Nonmydriatic · 45 degree fundus photograph · NIDEK AFC-230 — 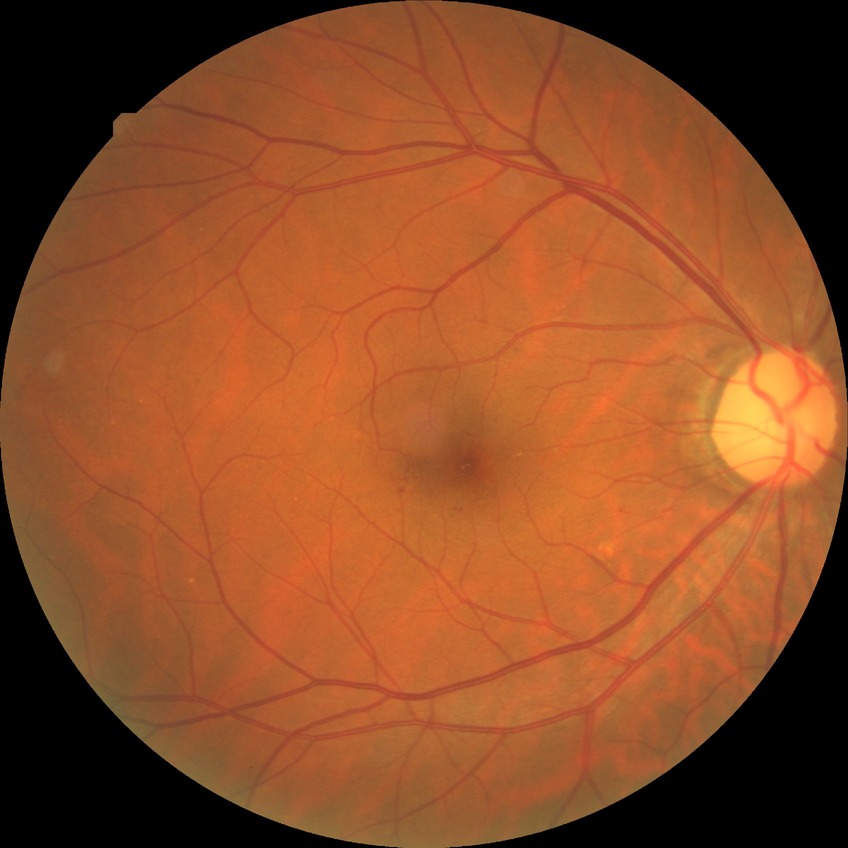 Annotations:
• modified Davis classification — simple diabetic retinopathy